Camera: Remidio FOP fundus camera, image size 1659x2212.
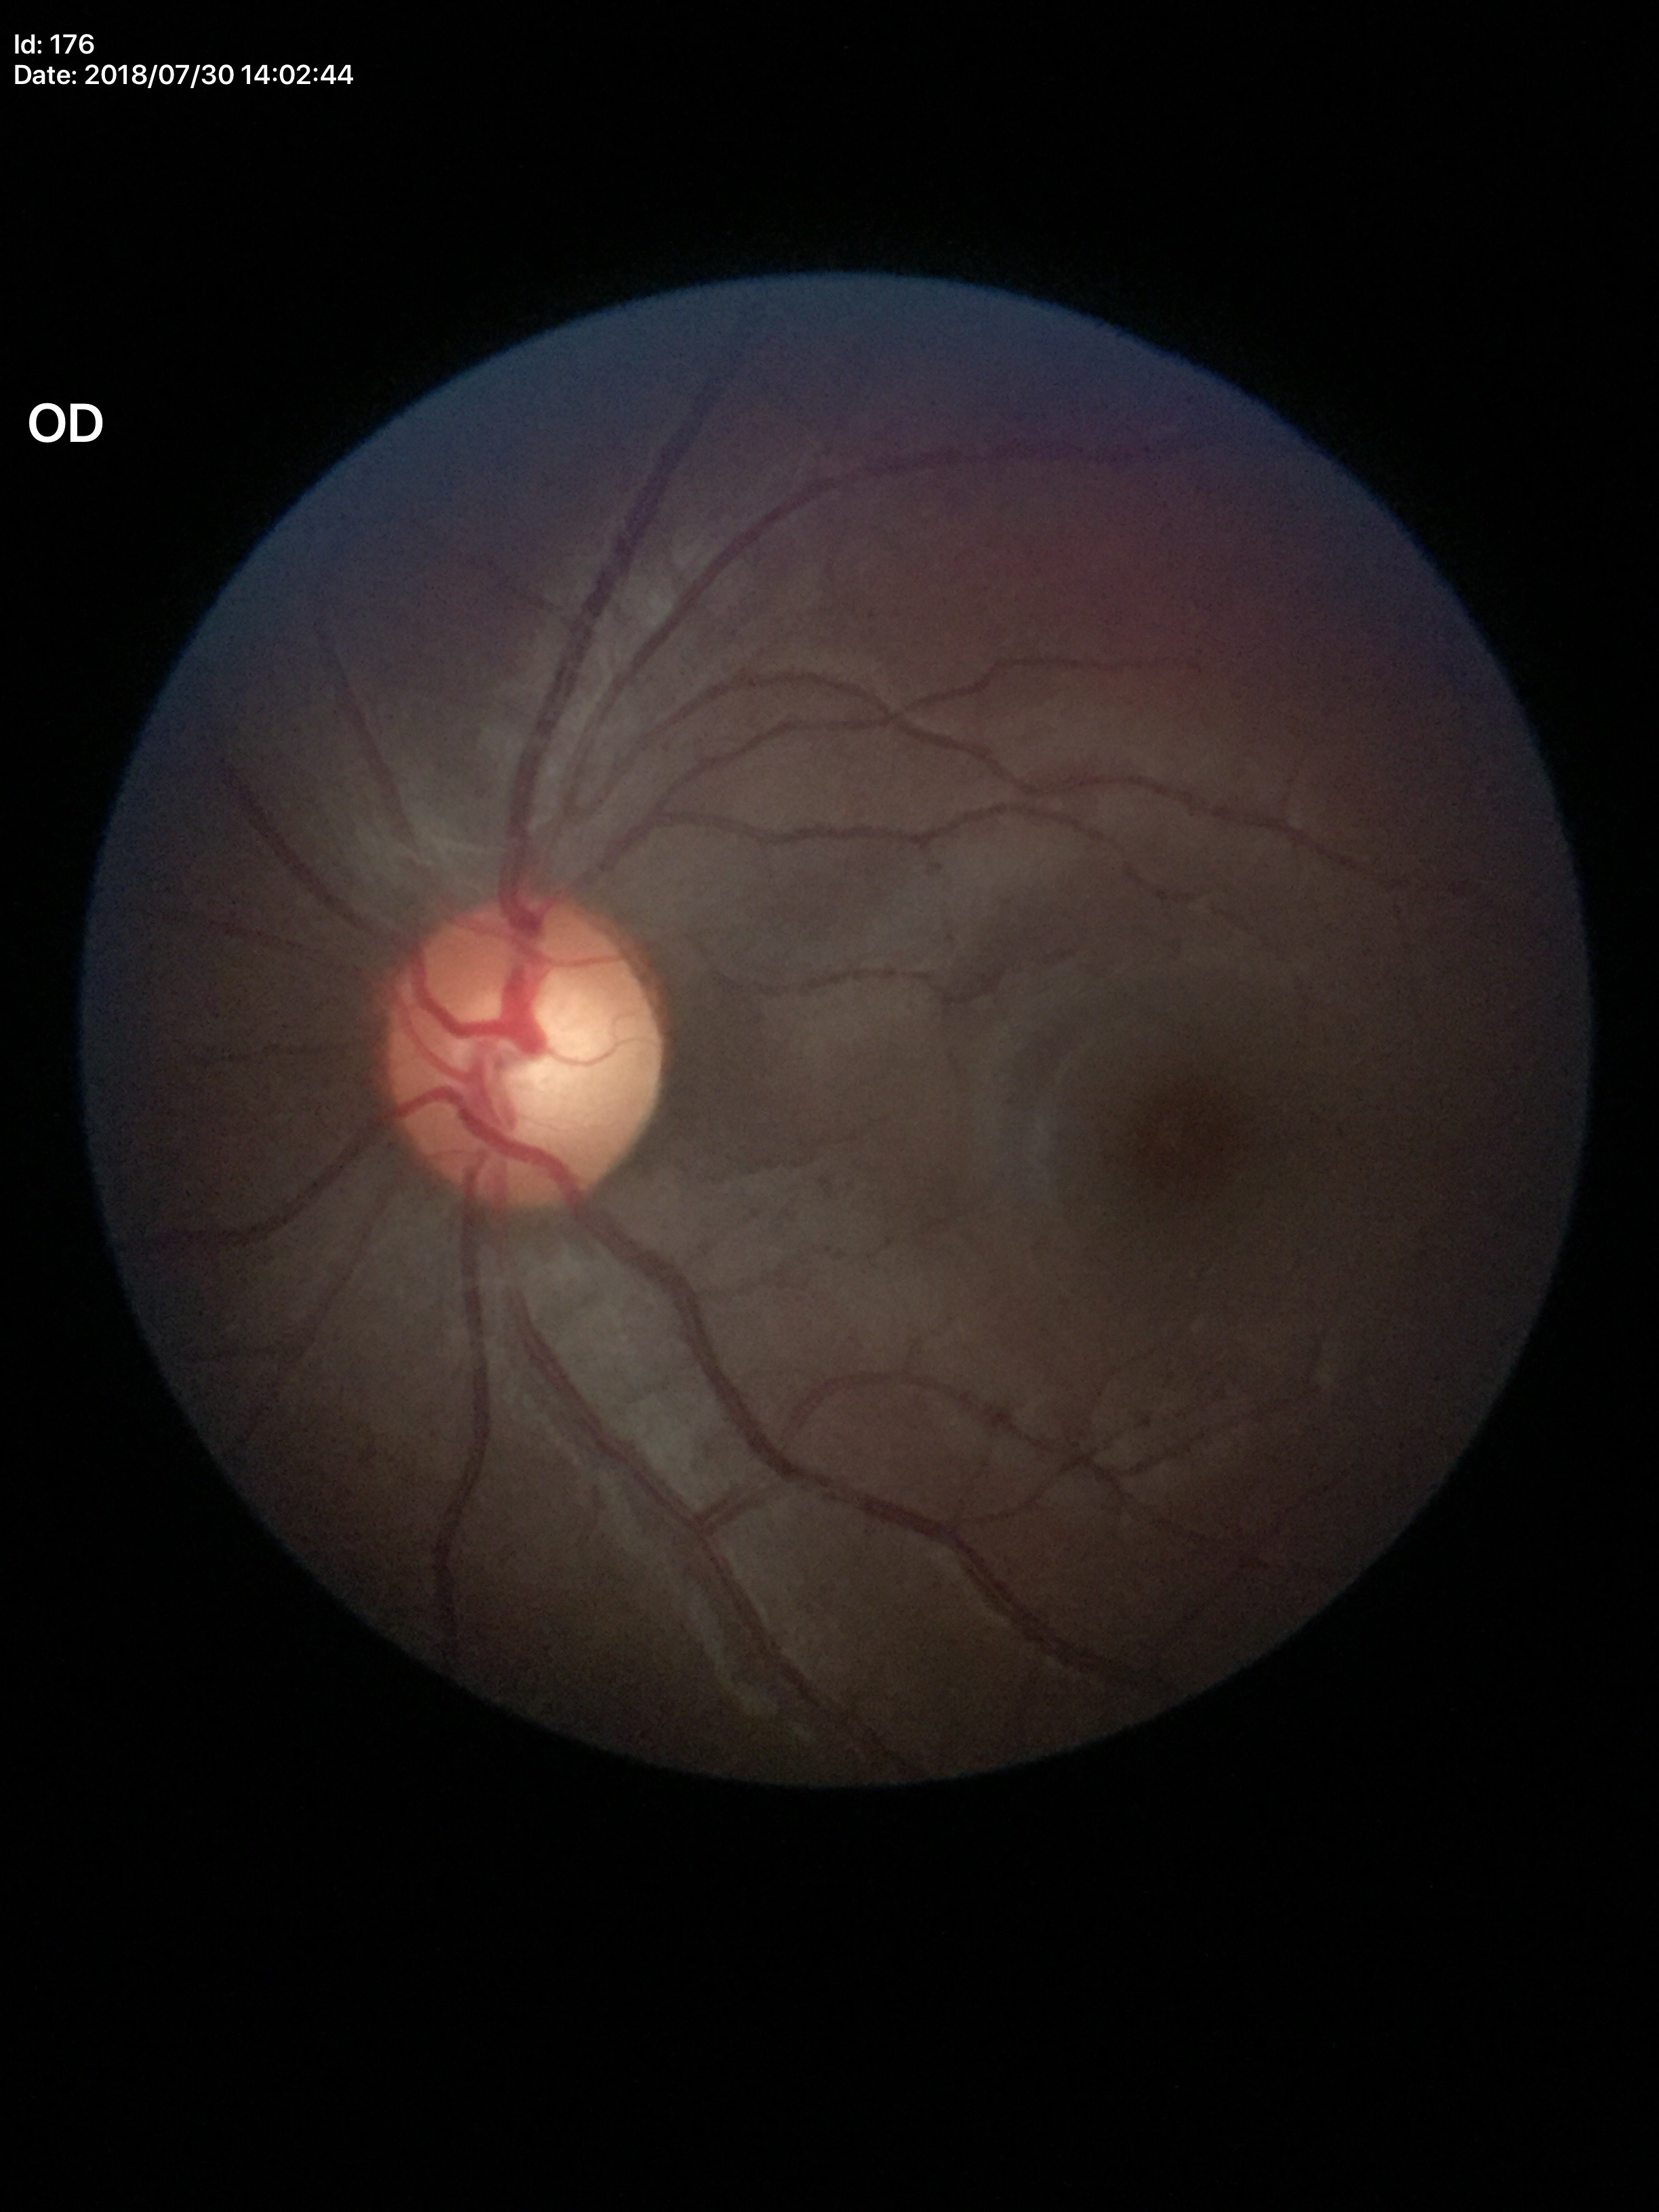
Optic disc analysis:
• Glaucoma screening — negative (2/5 graders called glaucoma suspect)
• vertical CDR — 0.59
• horizontal CDR — 0.60